2352 x 1568 pixels. CFP:
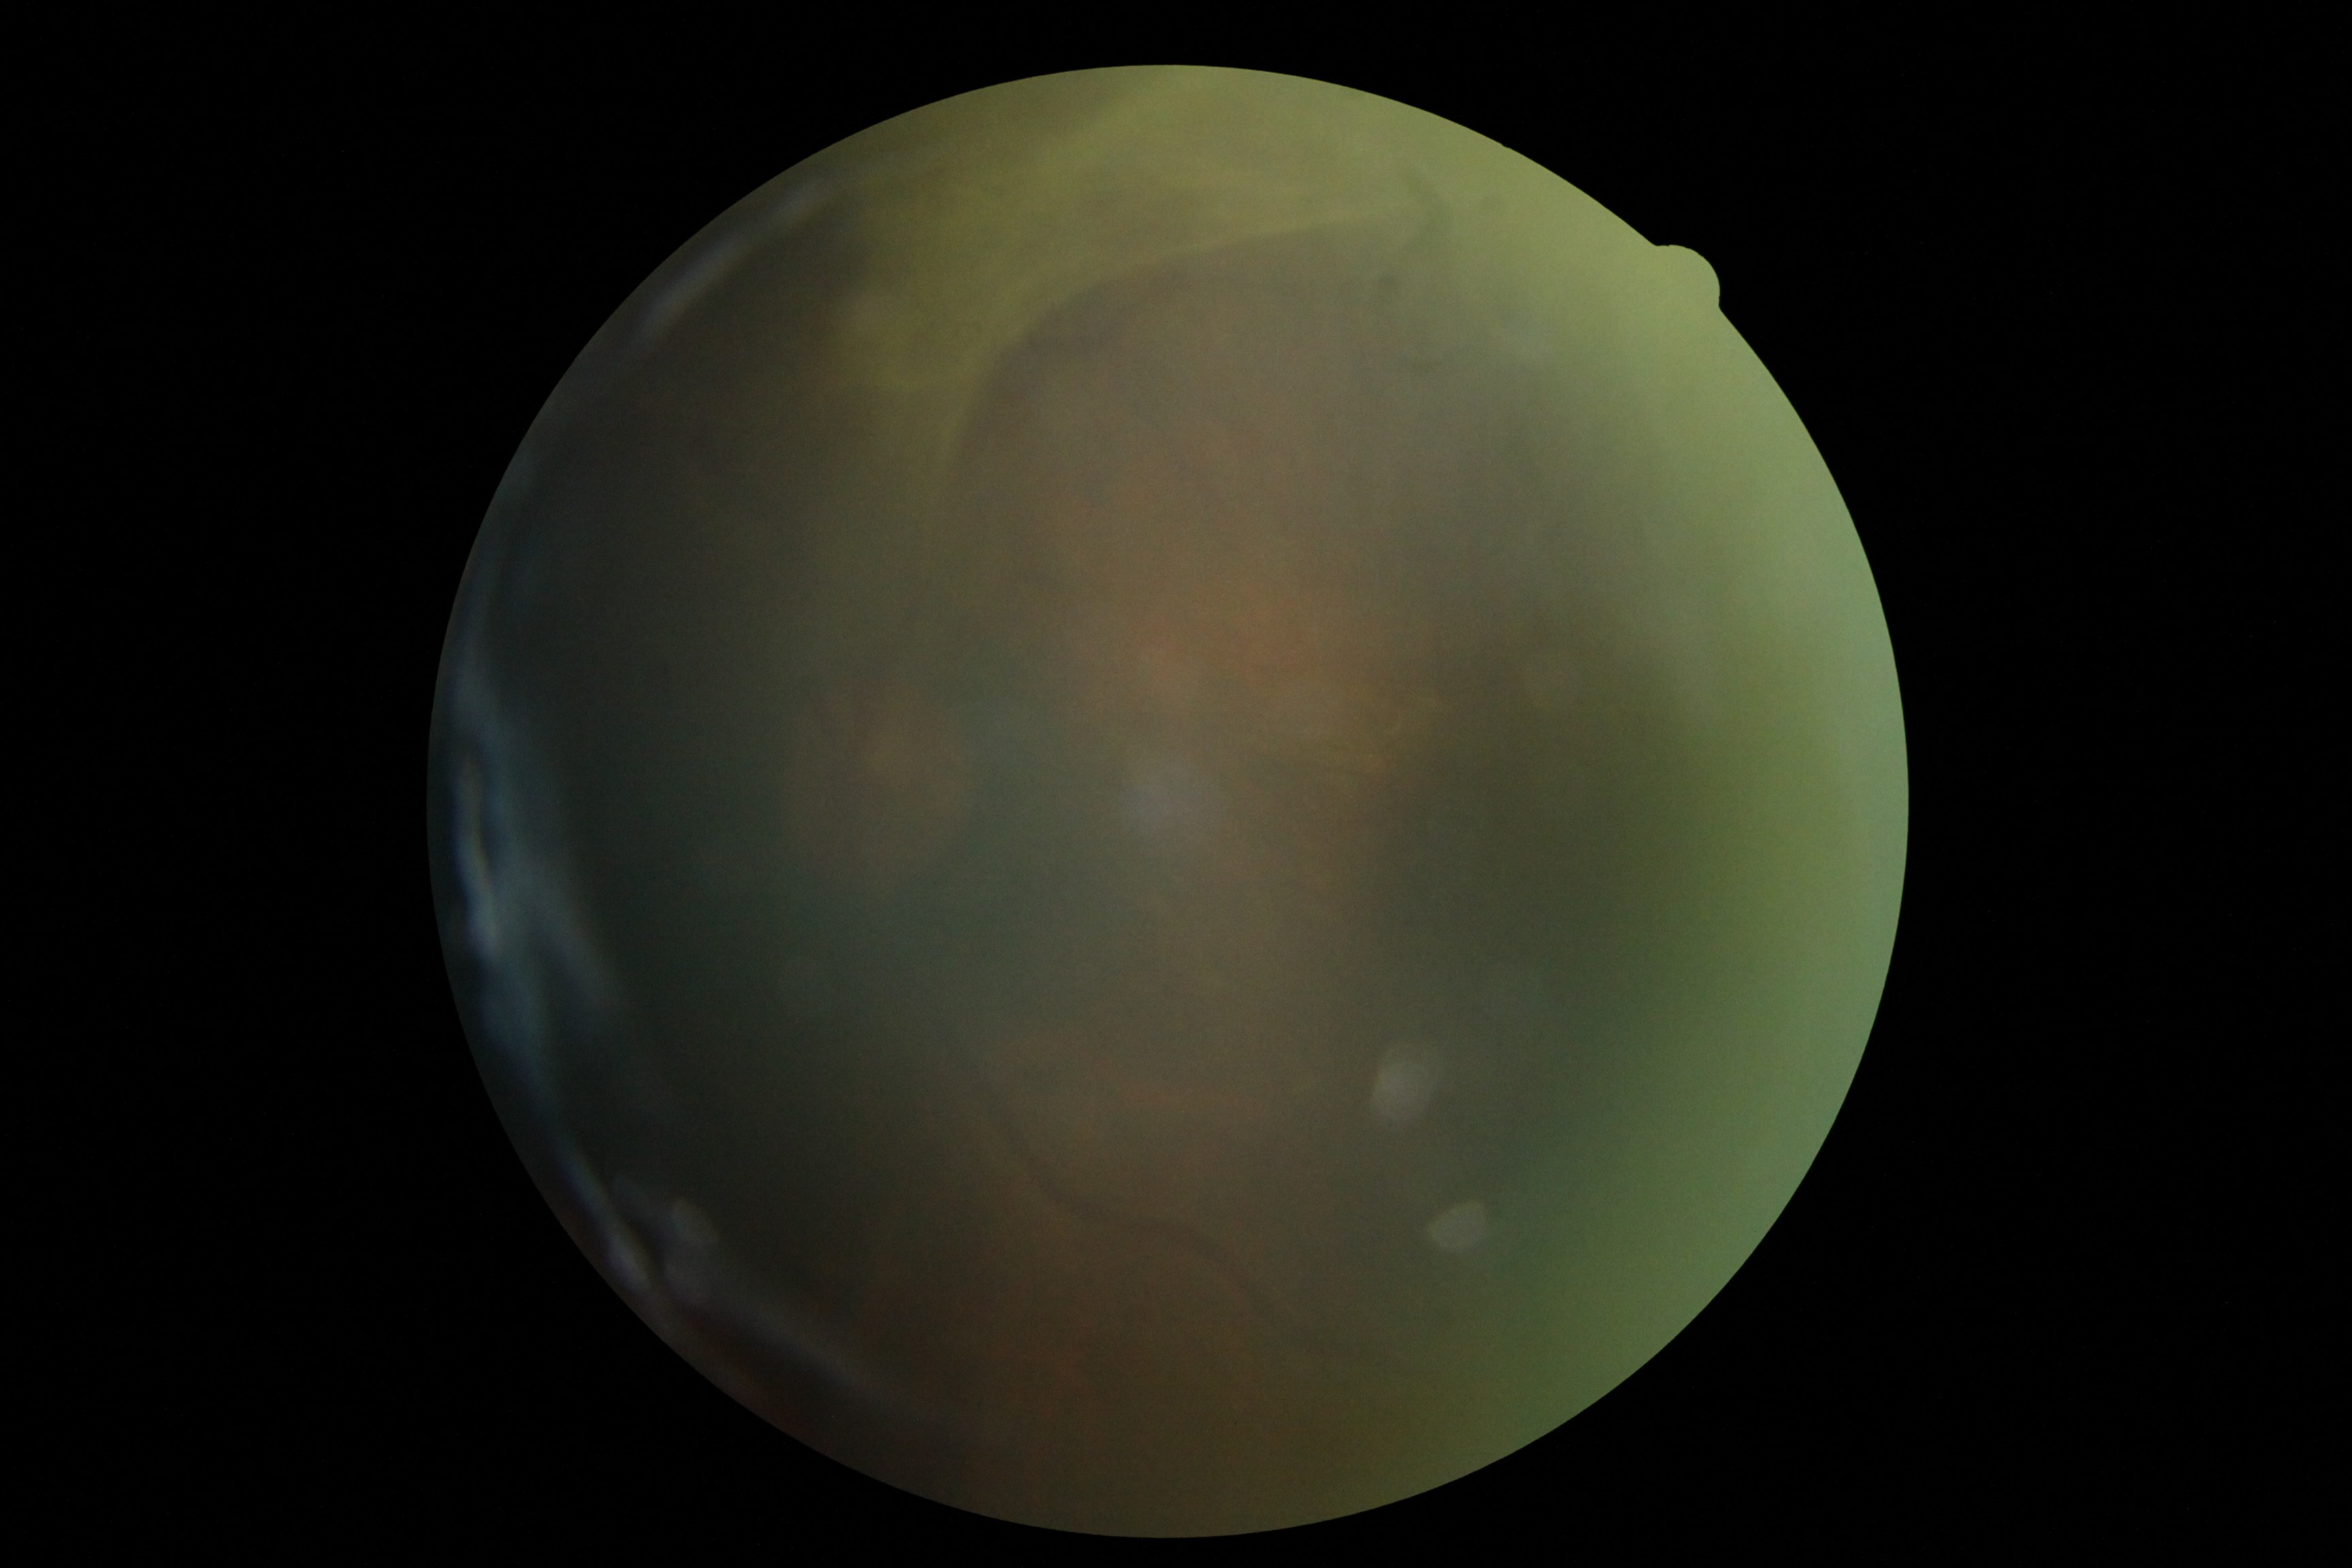
DR stage: grade 4.